45° field of view · image size 2048x1536 · CFP — 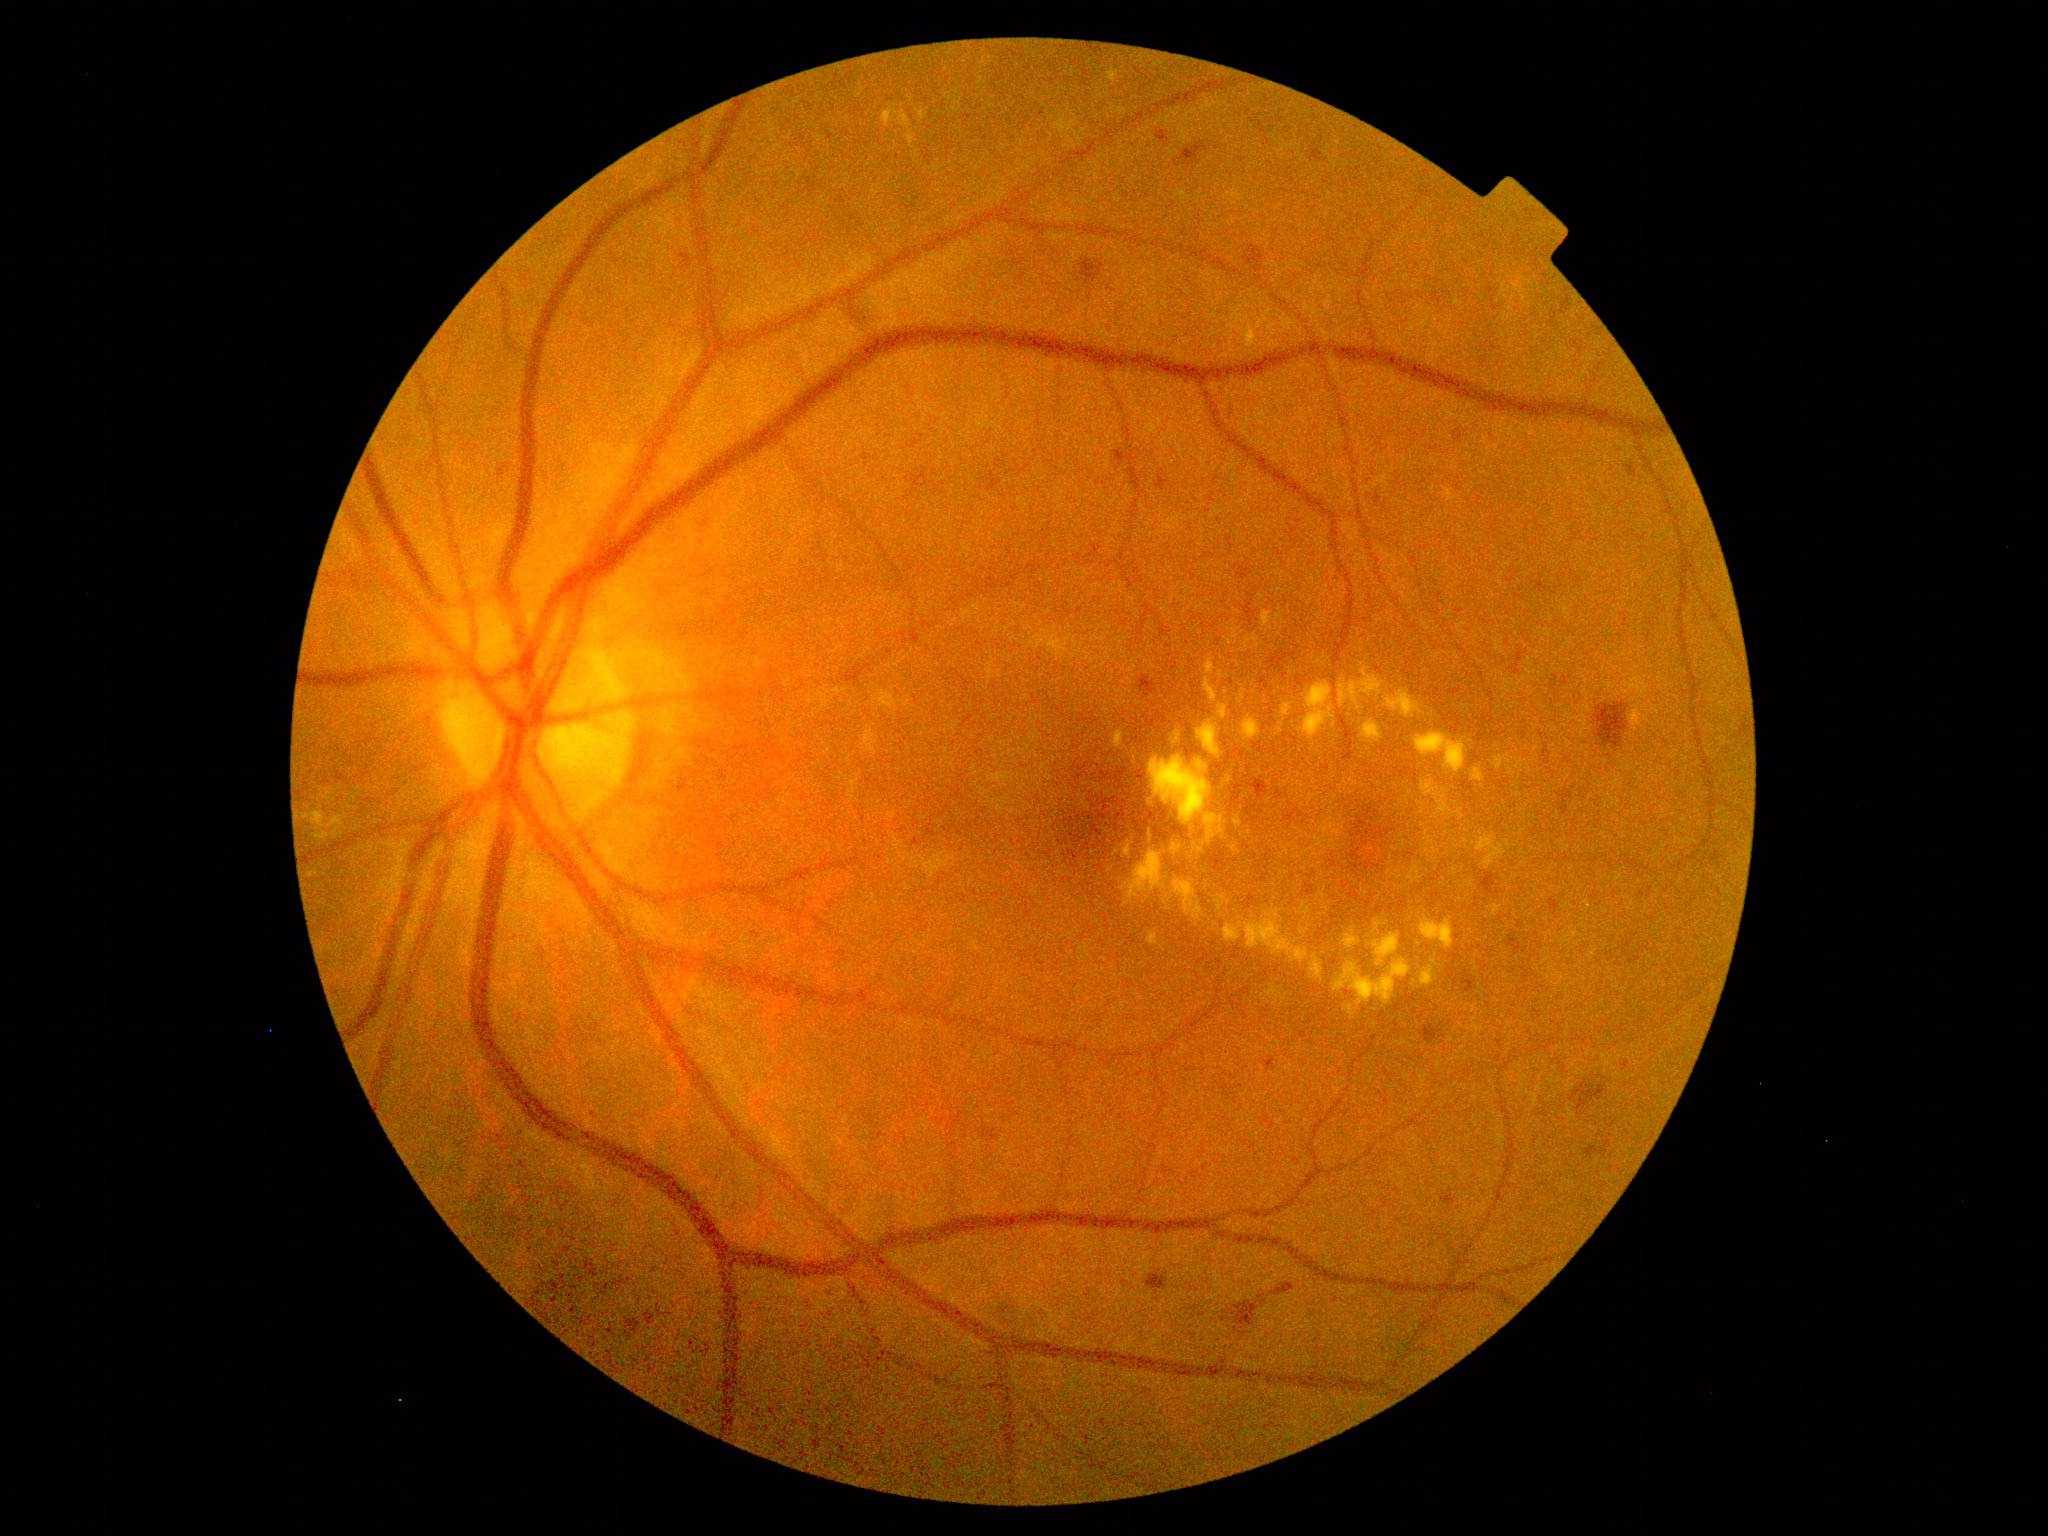
Diabetic retinopathy is 2/4; non-proliferative diabetic retinopathy
A subset of detected lesions:
hard exudates (subset): x1=1281, y1=843, x2=1295, y2=855; x1=1231, y1=845, x2=1242, y2=855; x1=1344, y1=779, x2=1348, y2=789; x1=1294, y1=848, x2=1315, y2=861; x1=1423, y1=829, x2=1441, y2=855; x1=1027, y1=626, x2=1073, y2=659; x1=1125, y1=846, x2=1131, y2=858; x1=874, y1=692, x2=911, y2=712
Hard exudates (small, approximate centers) near Point(1301, 797); Point(1121, 946); Point(1505, 958); Point(1471, 741); Point(1517, 691); Point(1352, 793); Point(1249, 862); Point(1353, 782); Point(1402, 837); Point(1332, 813); Point(1299, 776)